Color fundus photograph
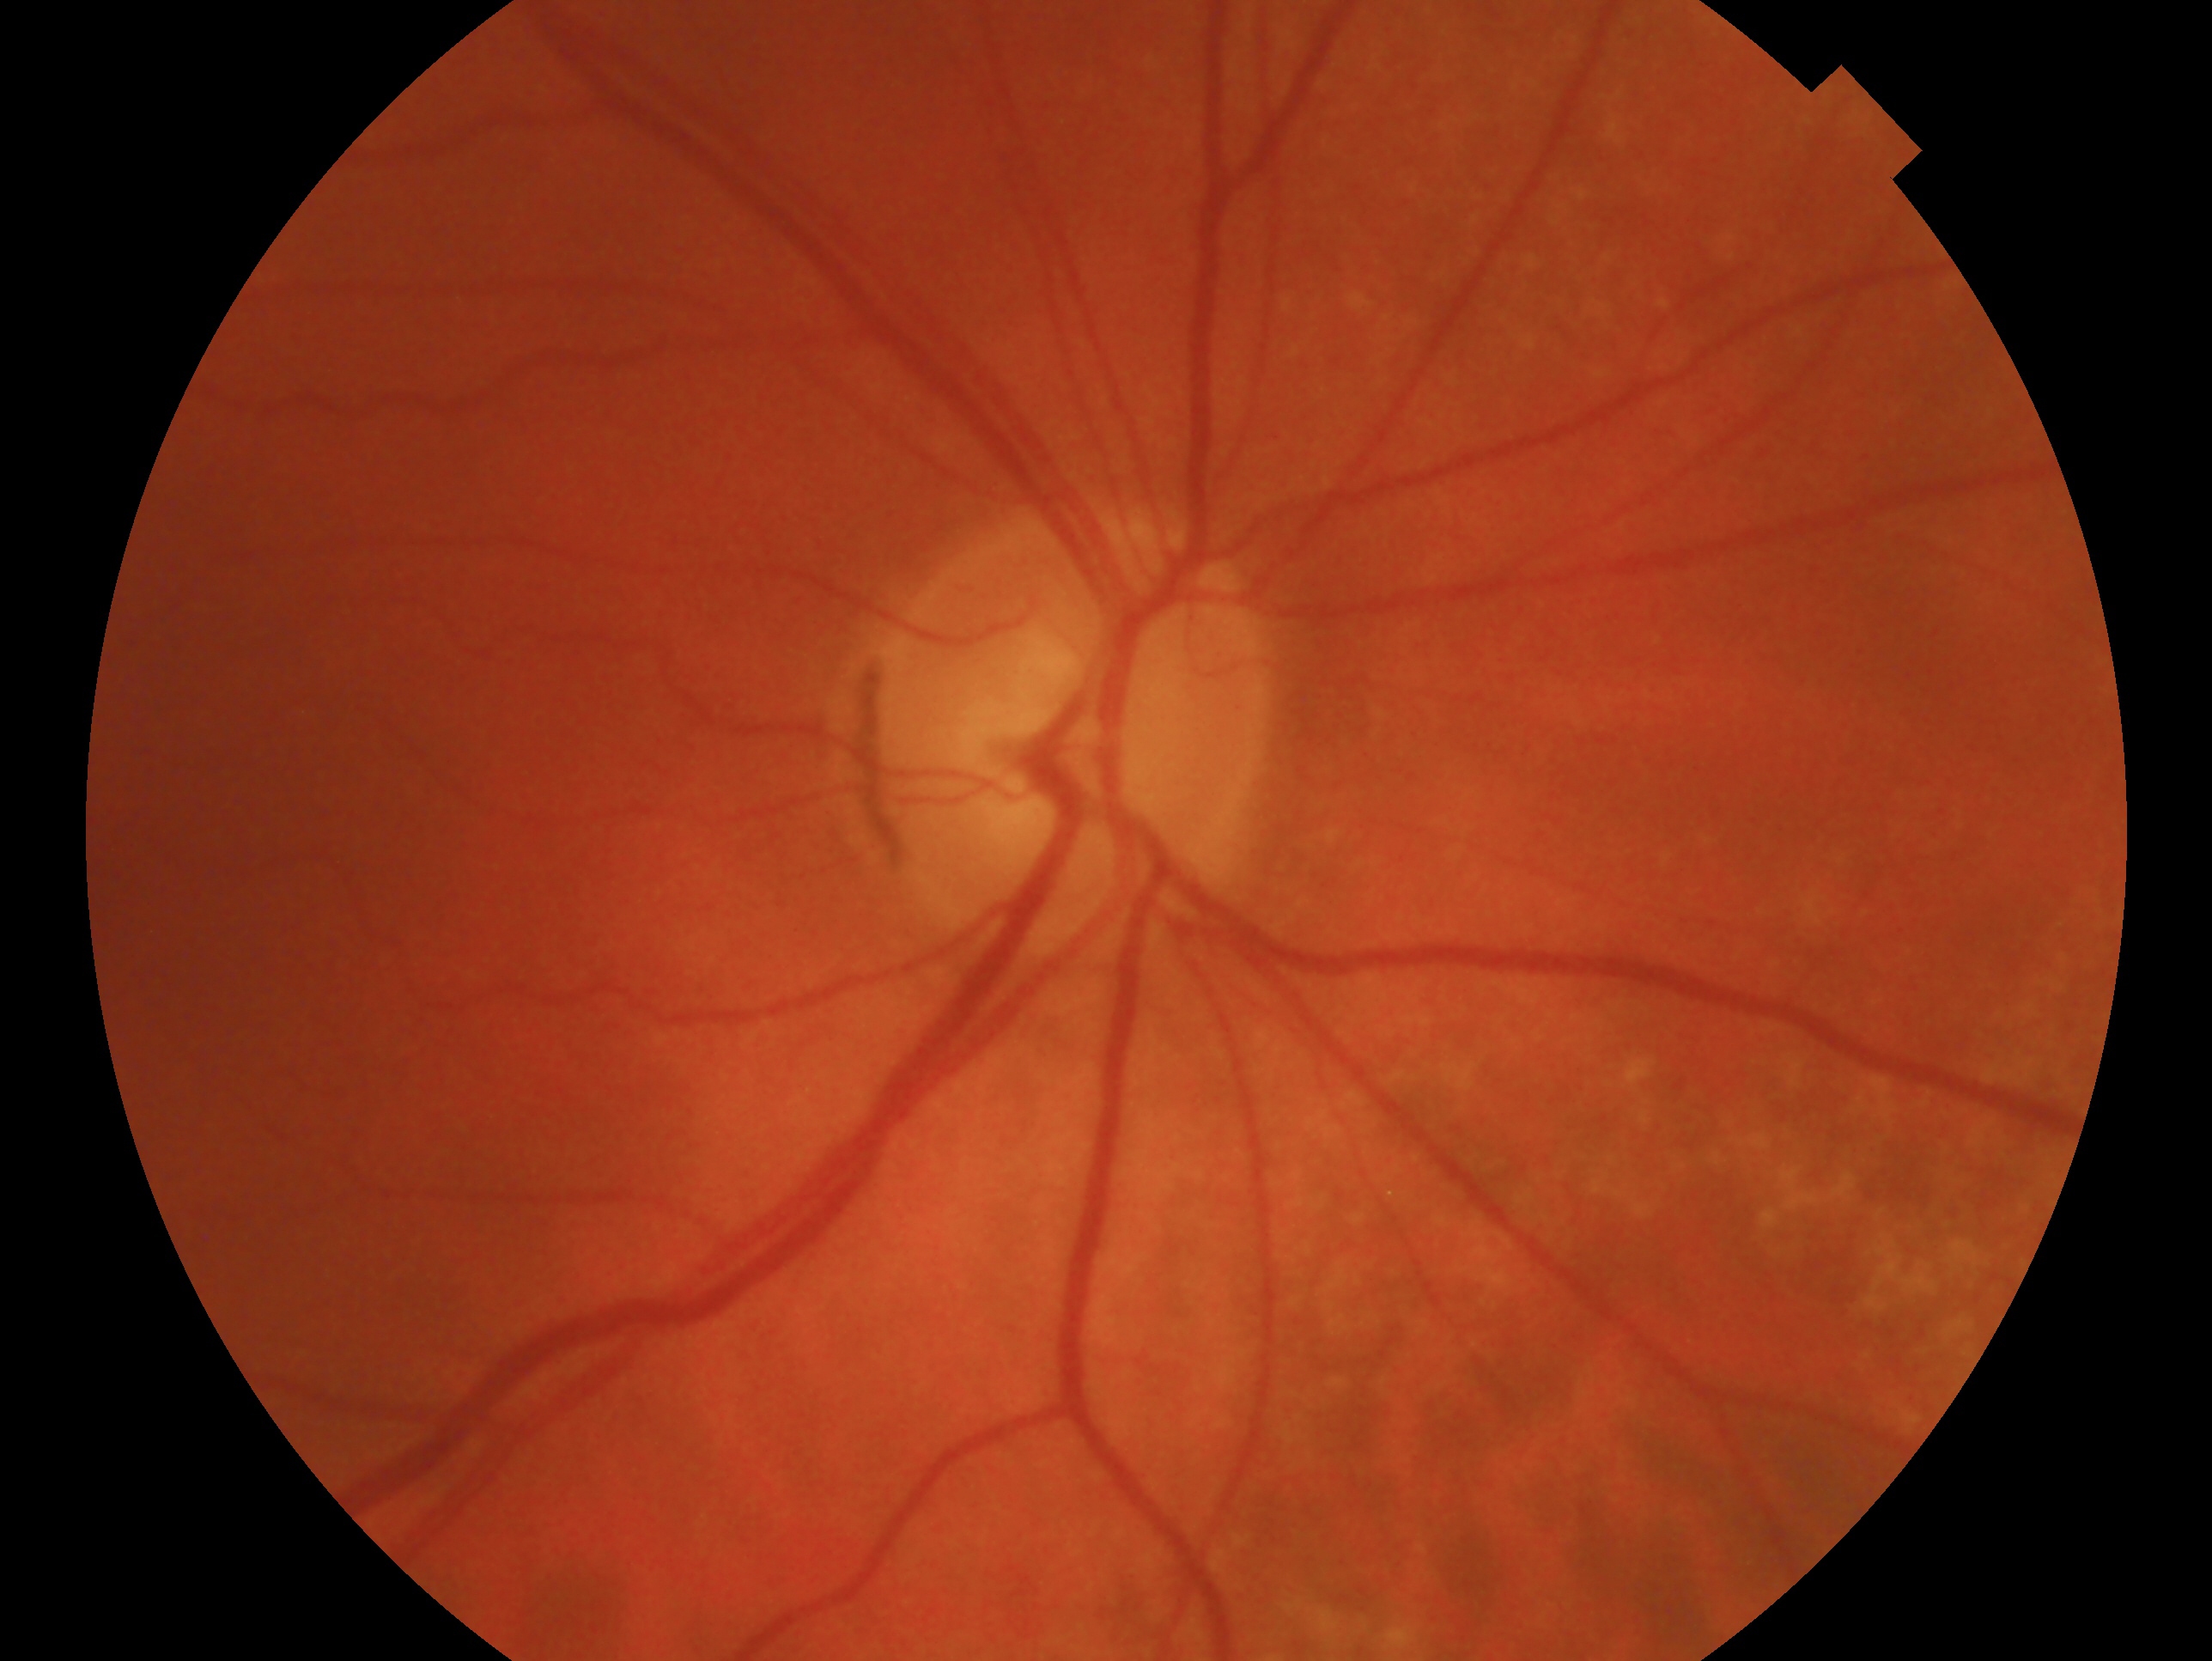 Diagnosis: glaucomatous optic neuropathy — clinically confirmed glaucoma with characteristic optic nerve damage. The image shows the right eye.